FOV: 45 degrees · 848 by 848 pixels · without pupil dilation · acquired with a NIDEK AFC-230.
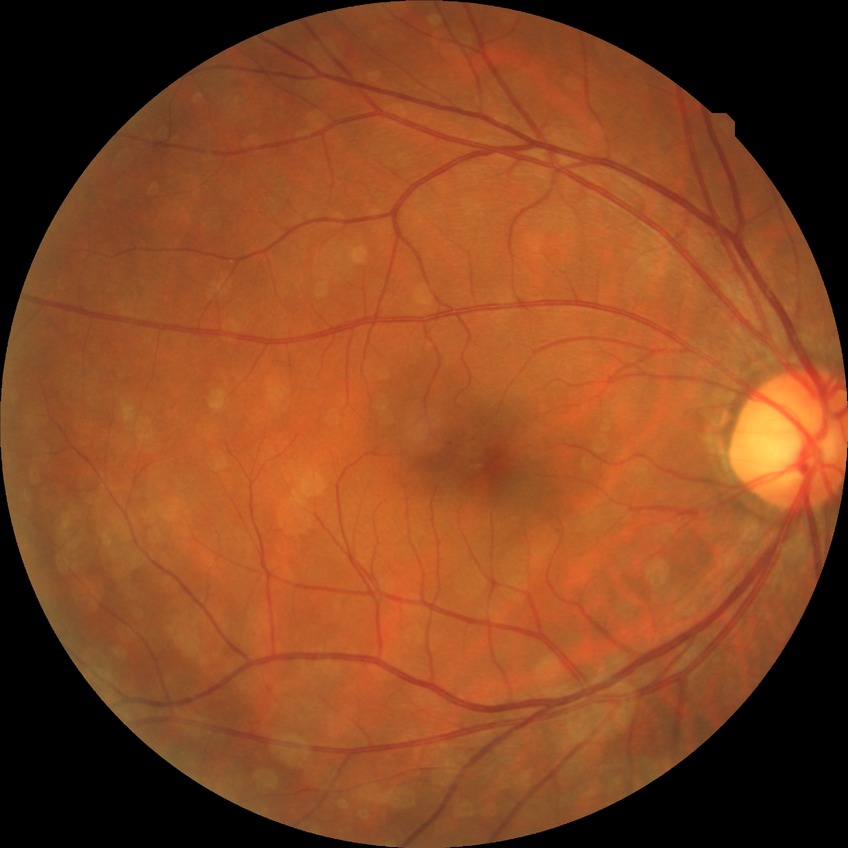

DR stage = SDR